Macula-centered · 50° FOV.
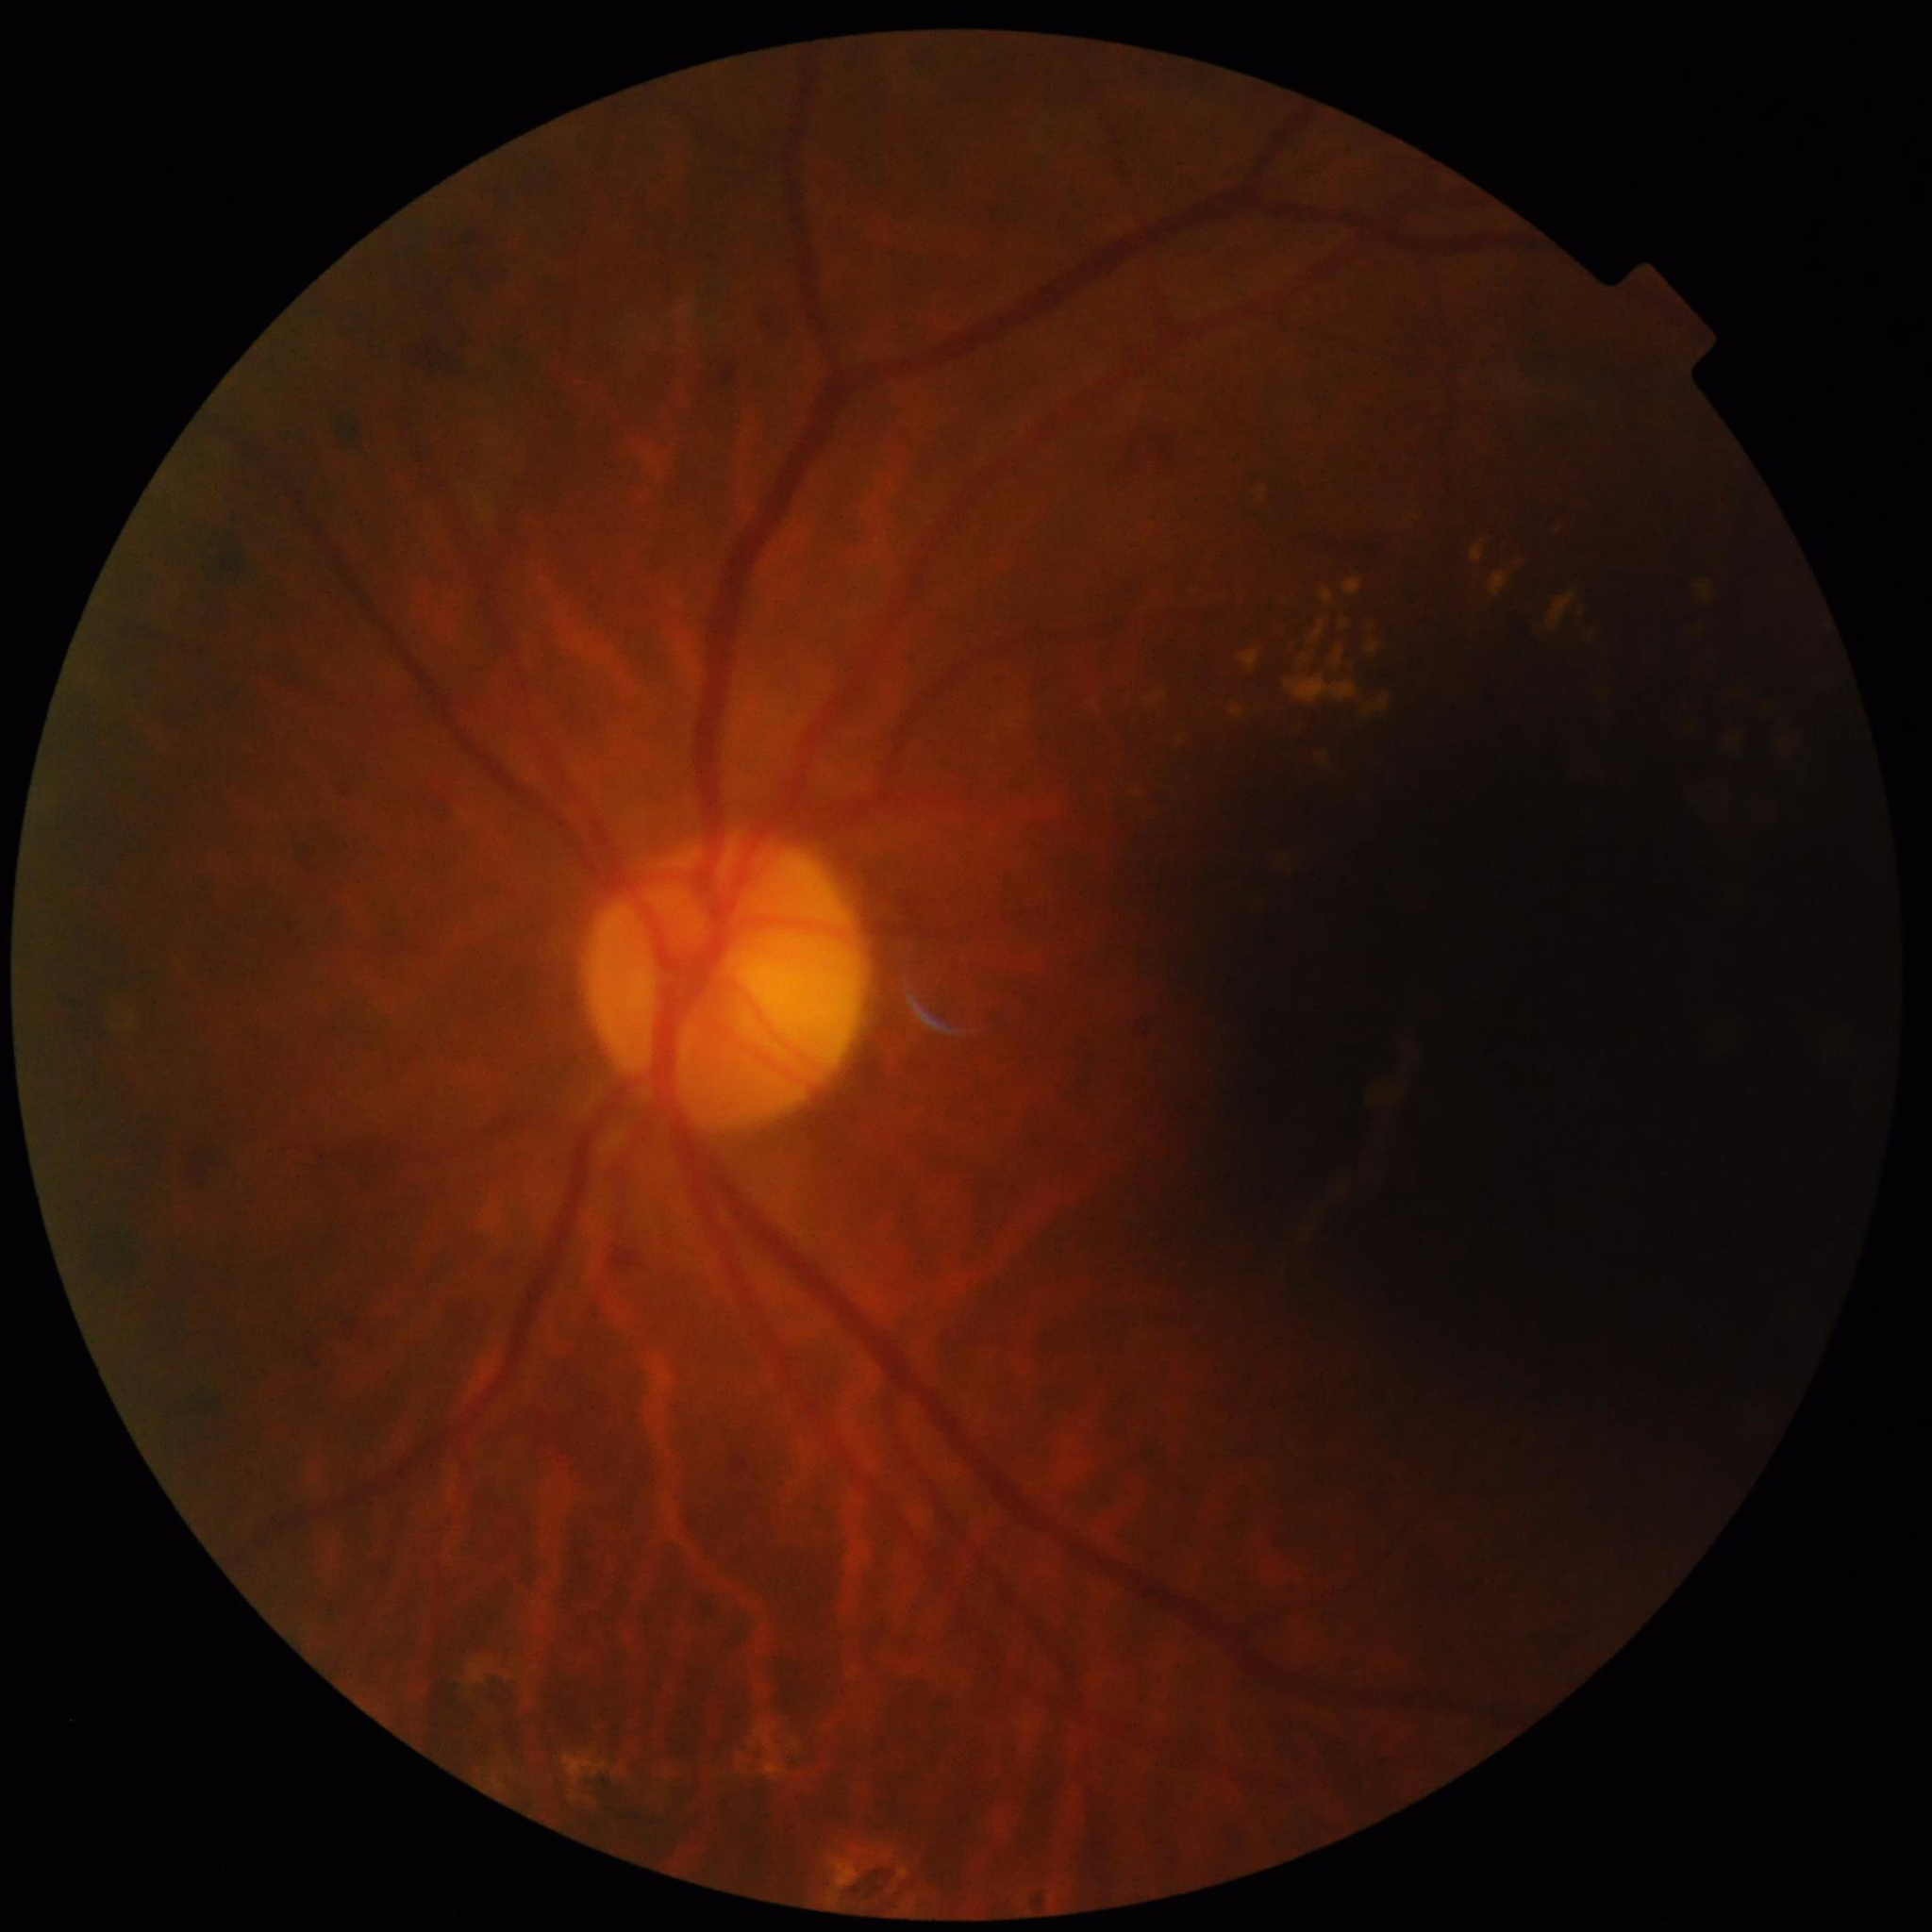

Image quality: concerns include illumination/color distortion, blur.
Fundus image of an eye with diabetic retinopathy.